Retinal fundus photograph; image size 848x848; FOV: 45 degrees; modified Davis classification:
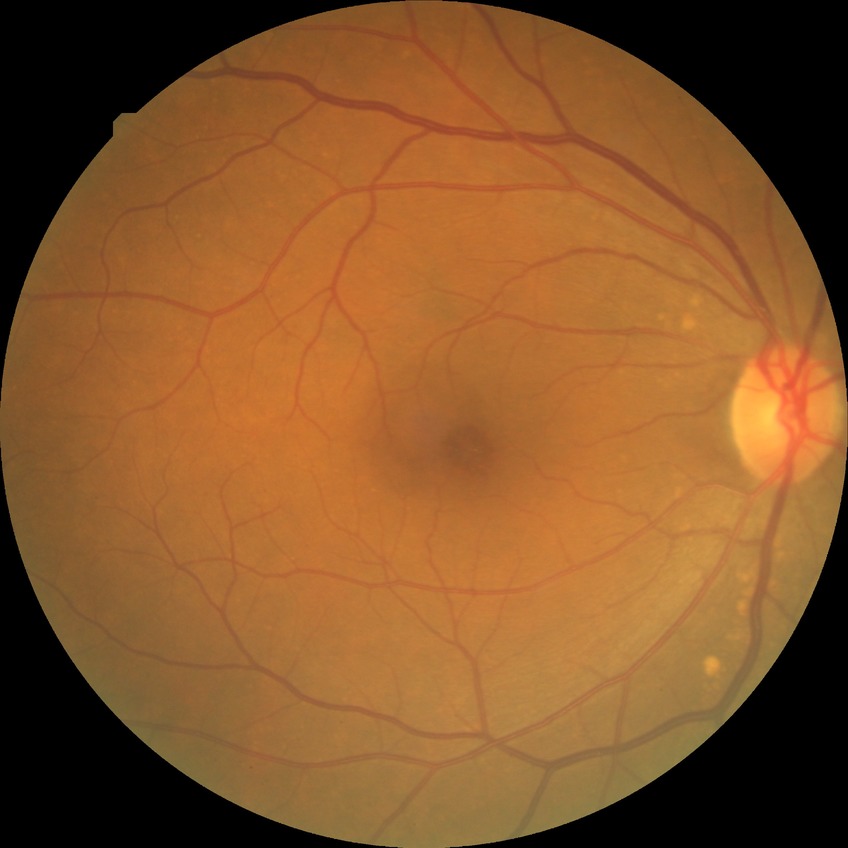 Diabetic retinopathy (DR) is NDR (no diabetic retinopathy).